Undilated pupil:
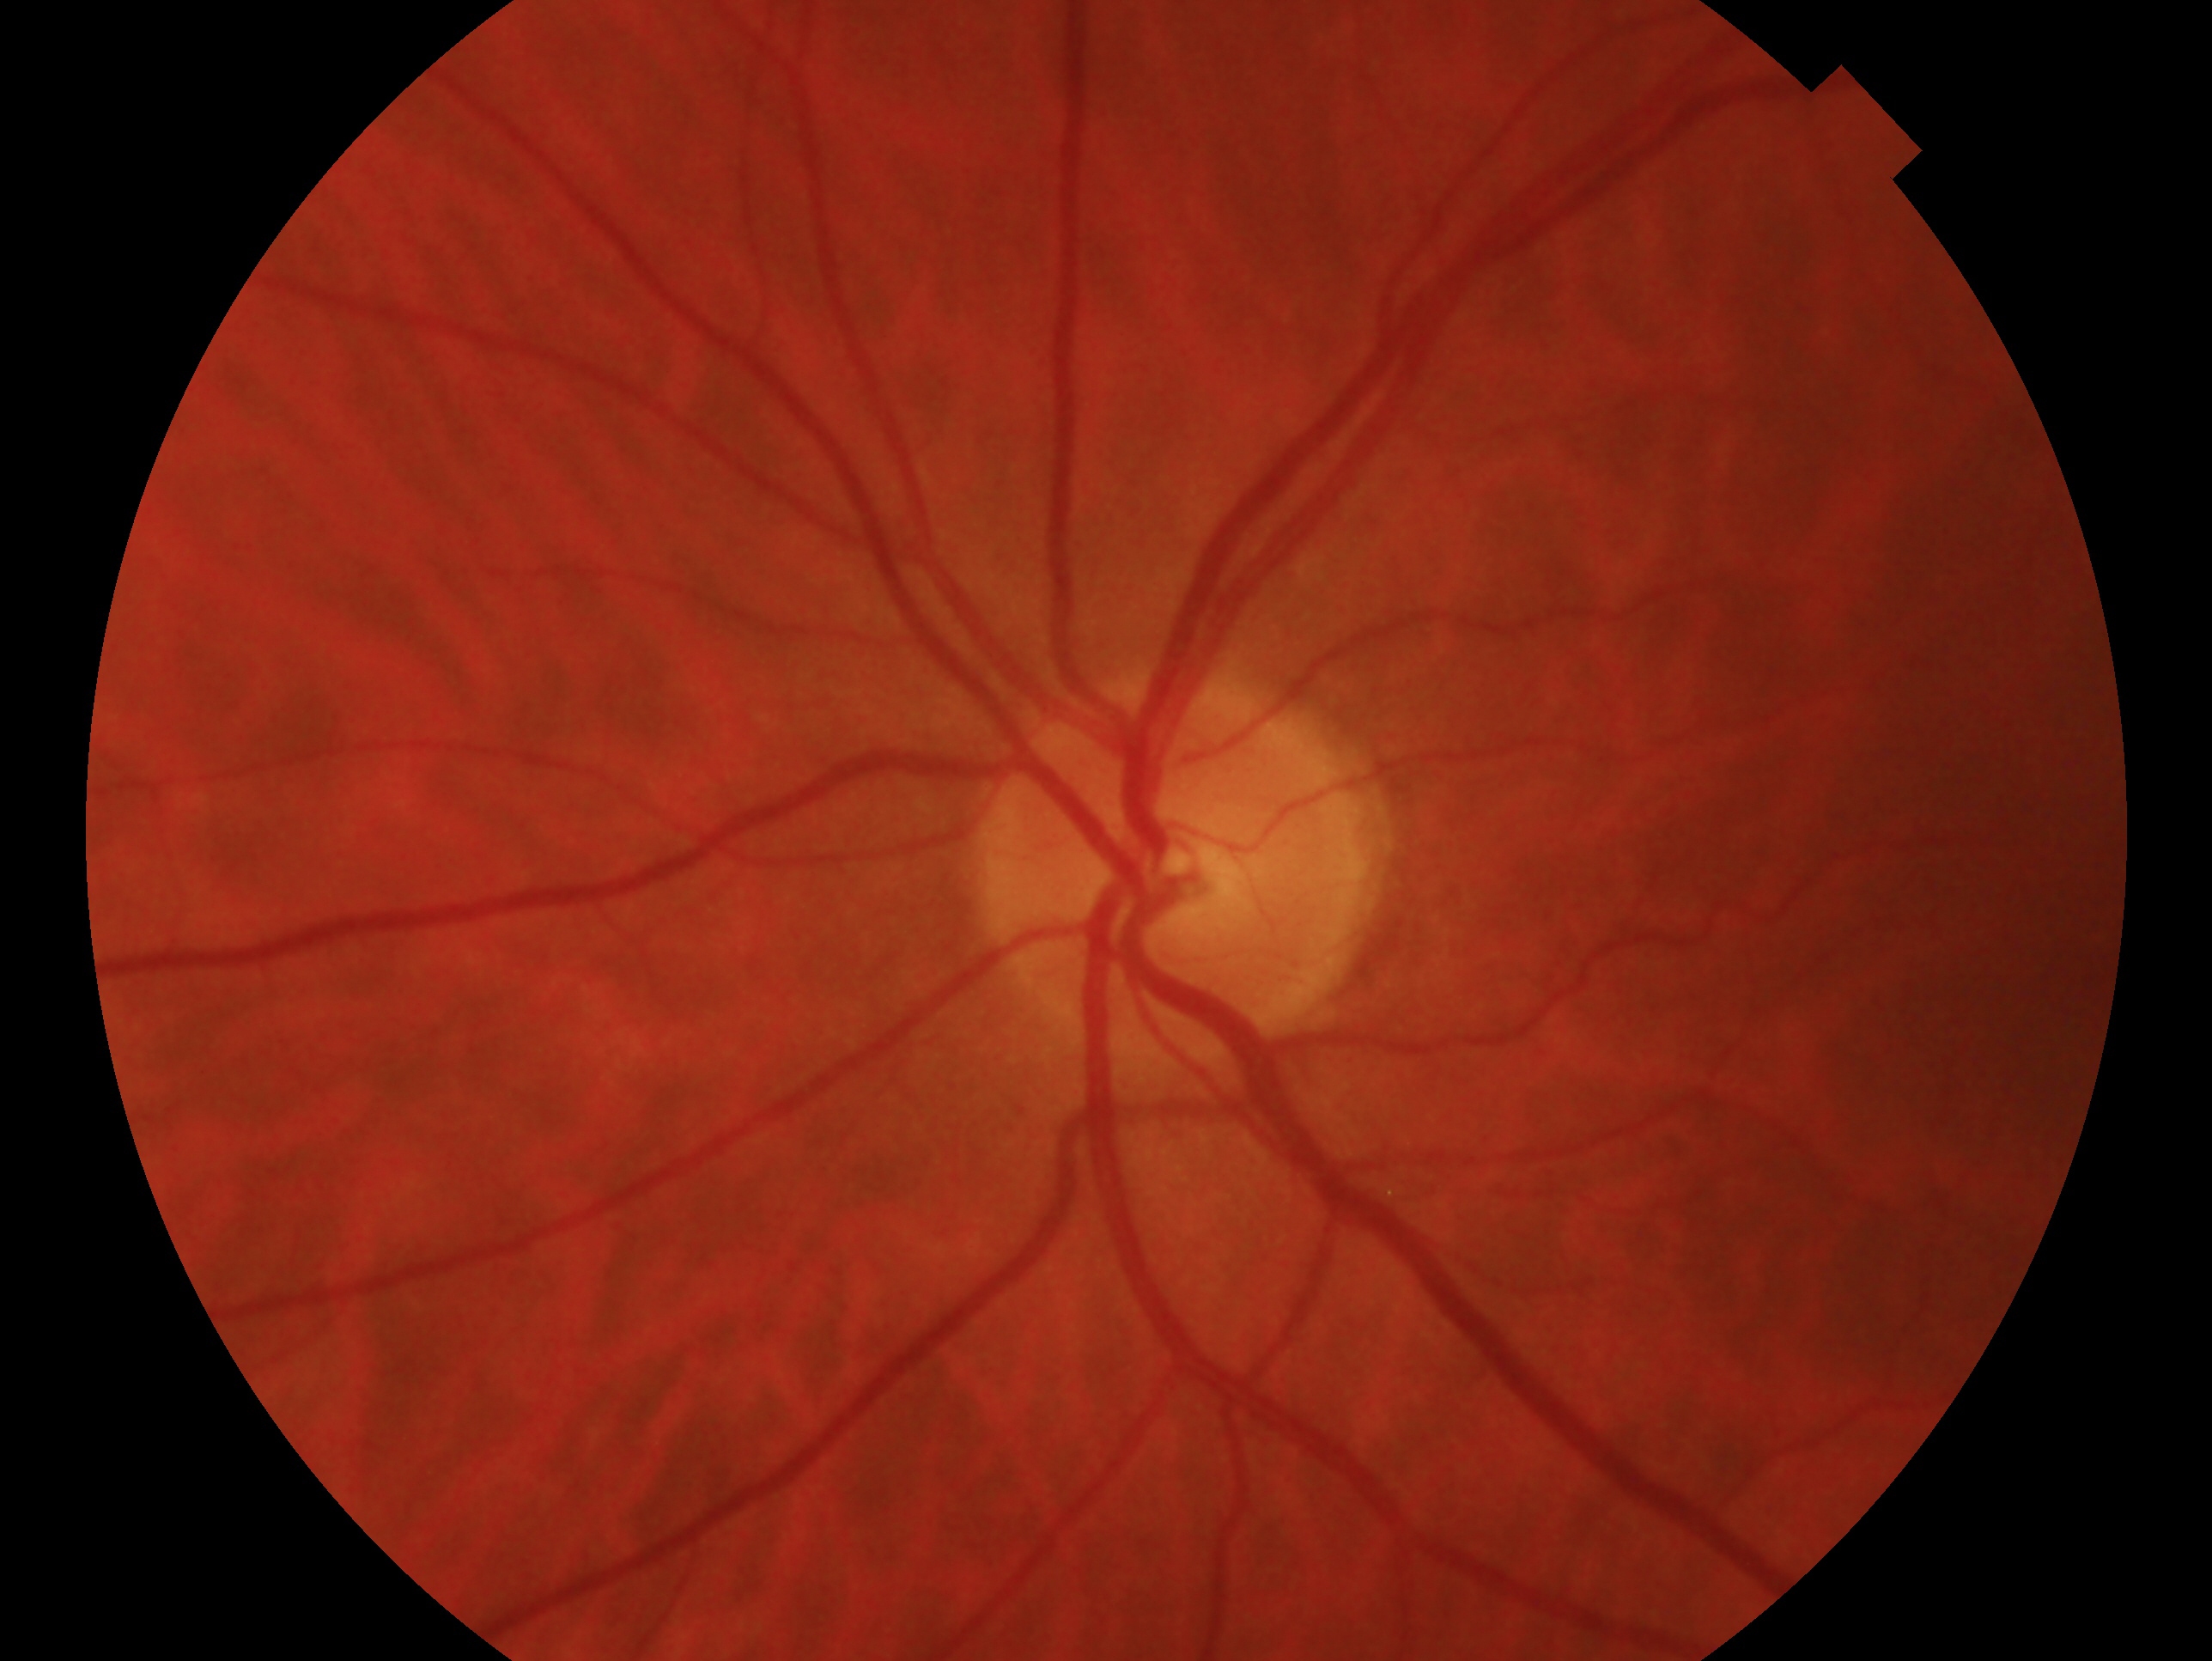

Glaucoma assessment — no glaucoma. This is the oculus sinister.